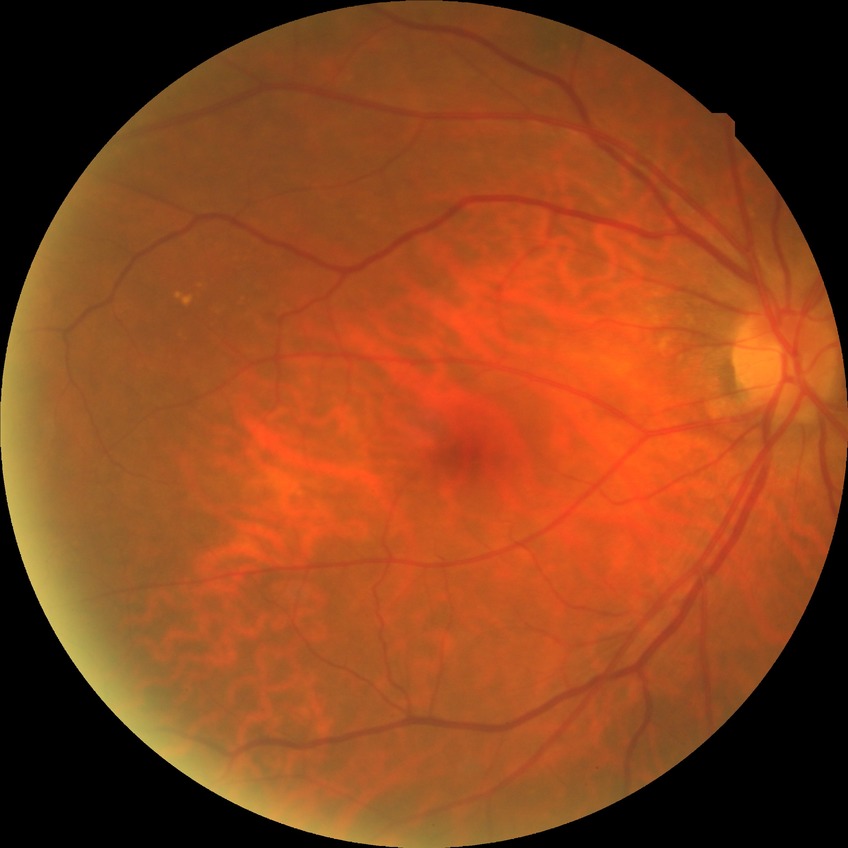 Davis grading: no diabetic retinopathy.